FOV: 45 degrees · CFP — 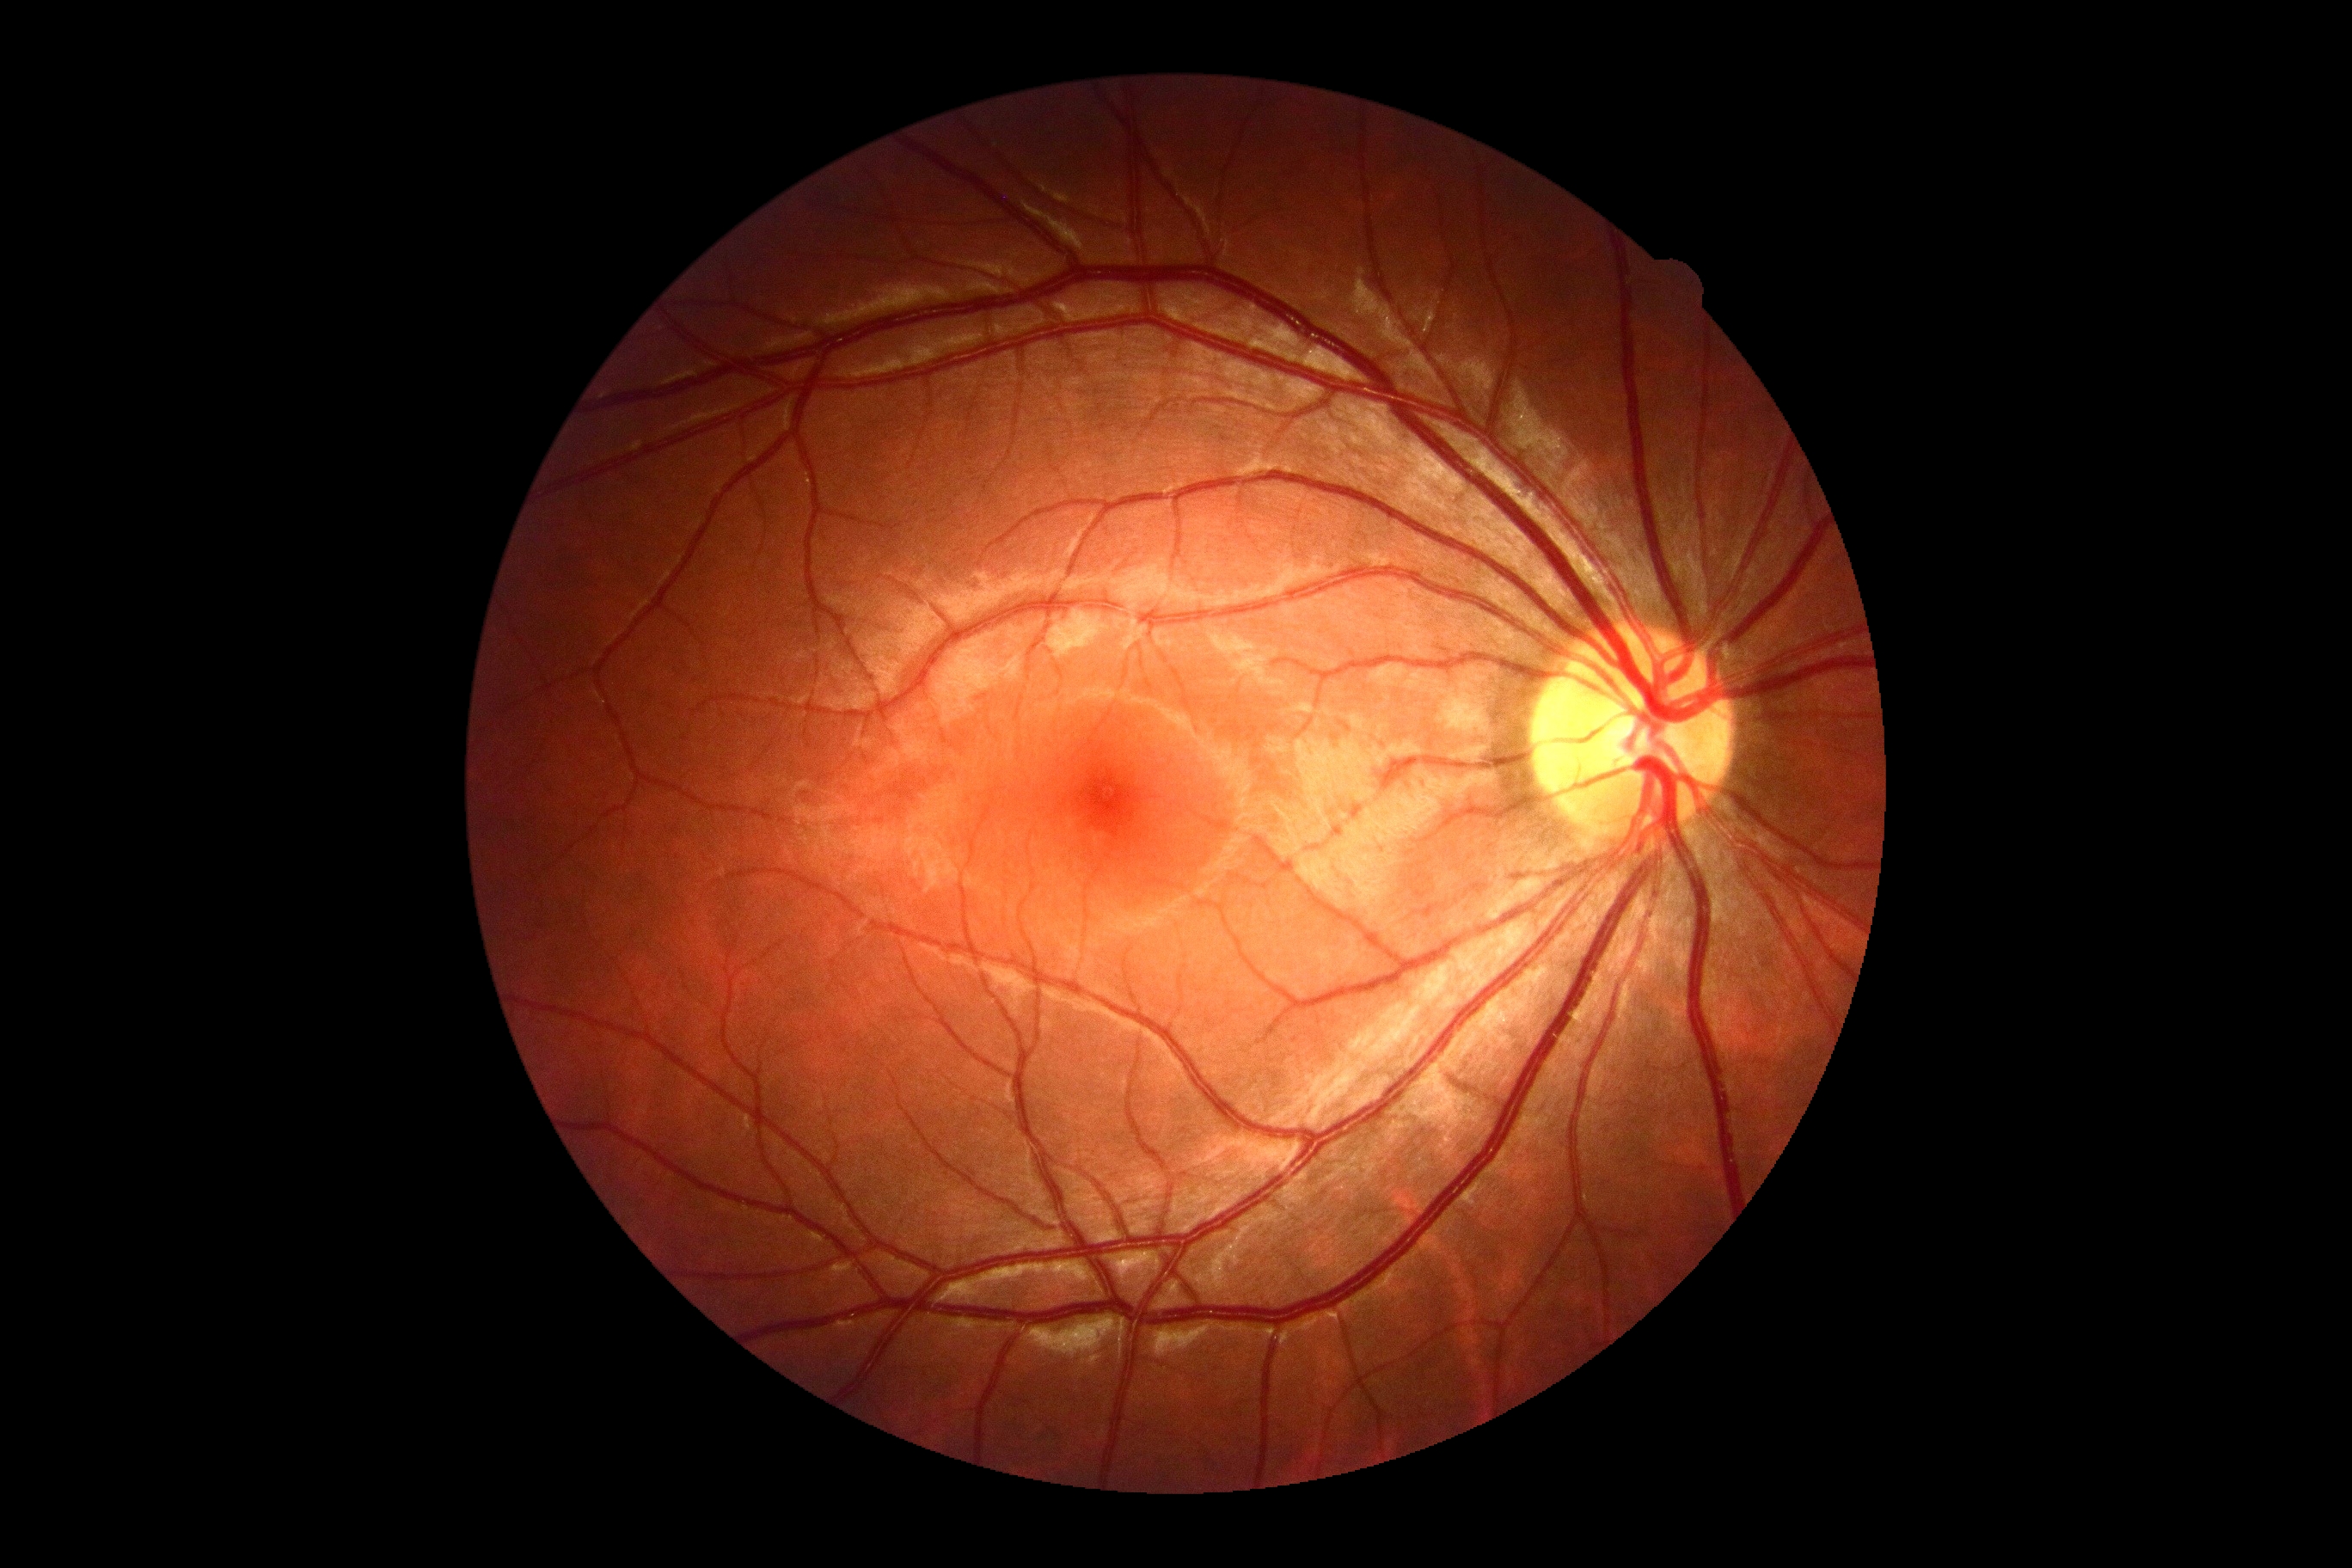
No DR findings. DR stage is 0/4.